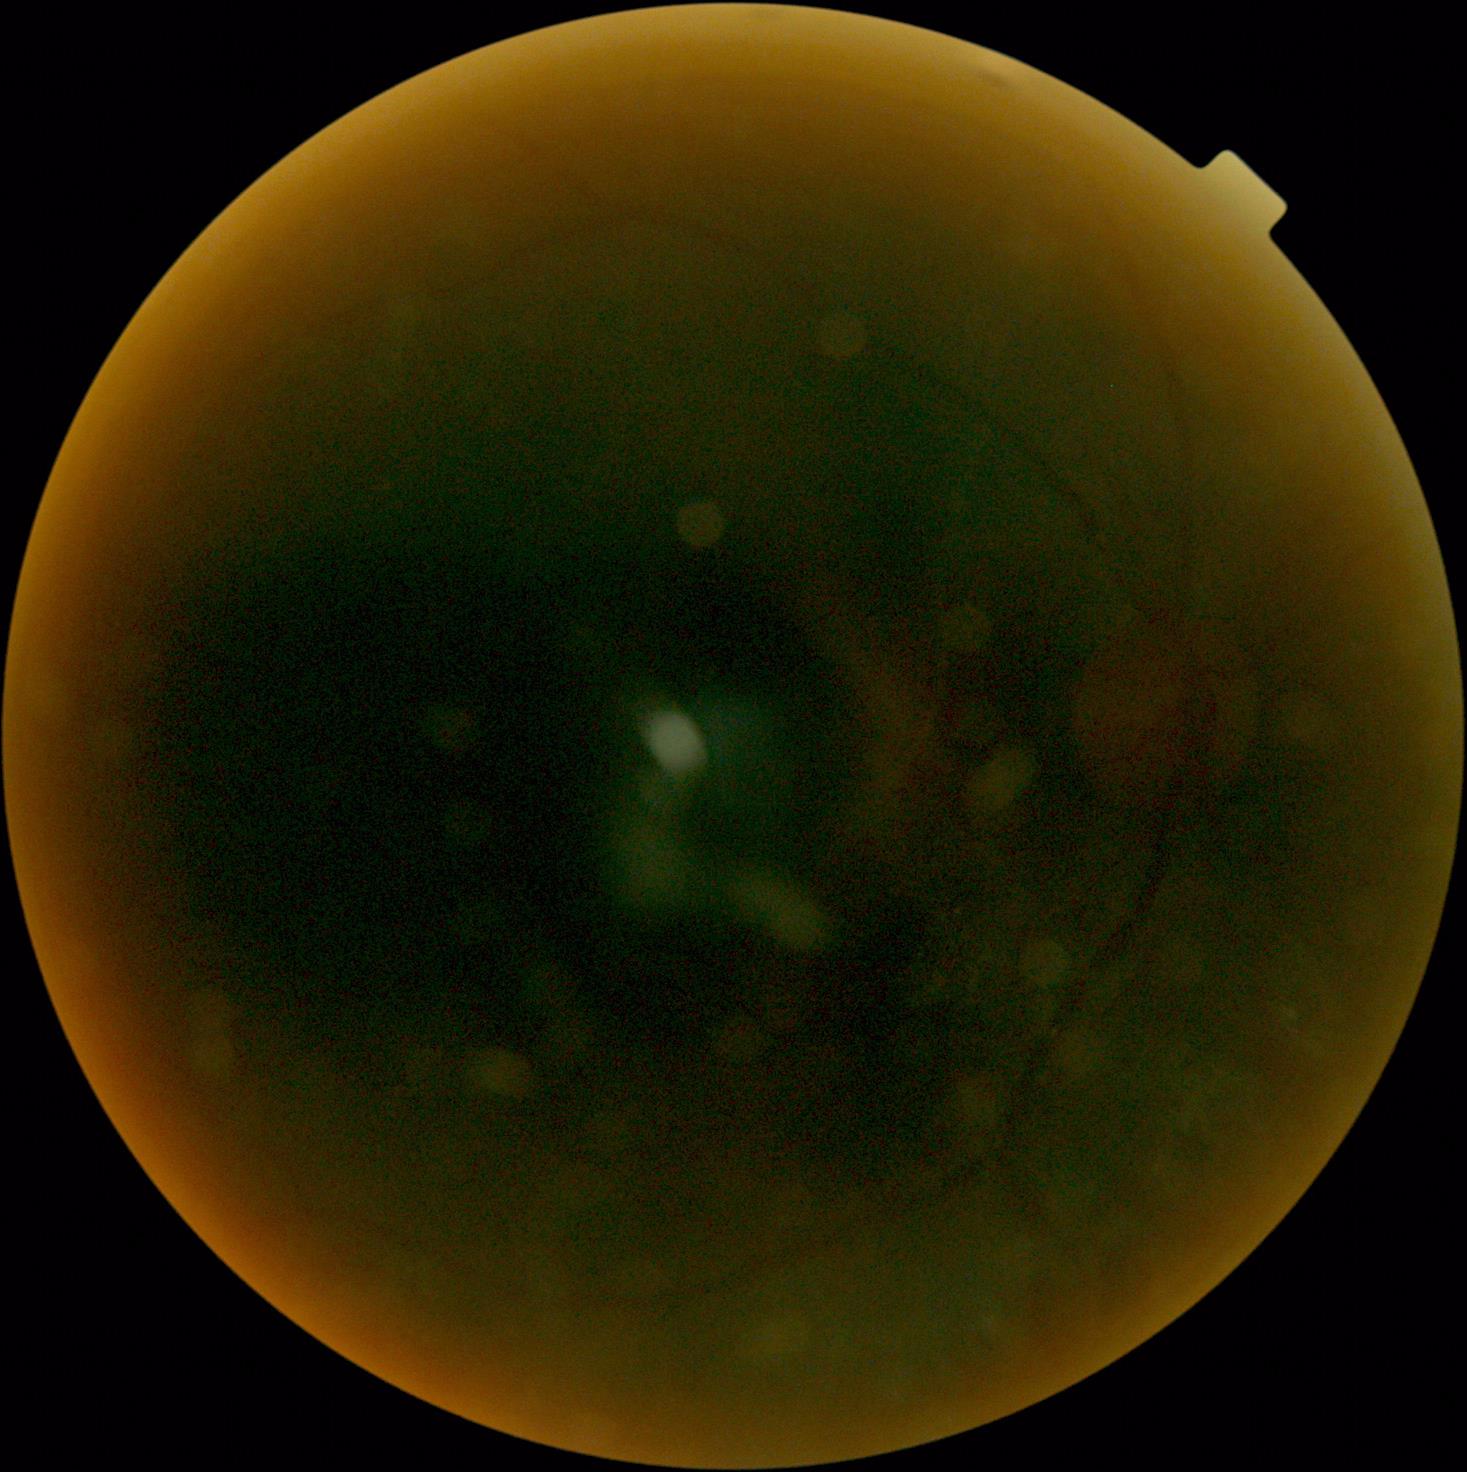 Diabetic retinopathy severity is ungradable.